Optic disc-centered crop: 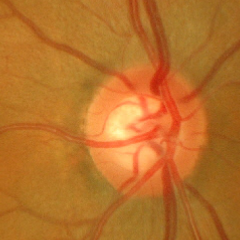 Glaucoma assessment: no glaucomatous changes.